FOV: 45 degrees; color fundus photograph
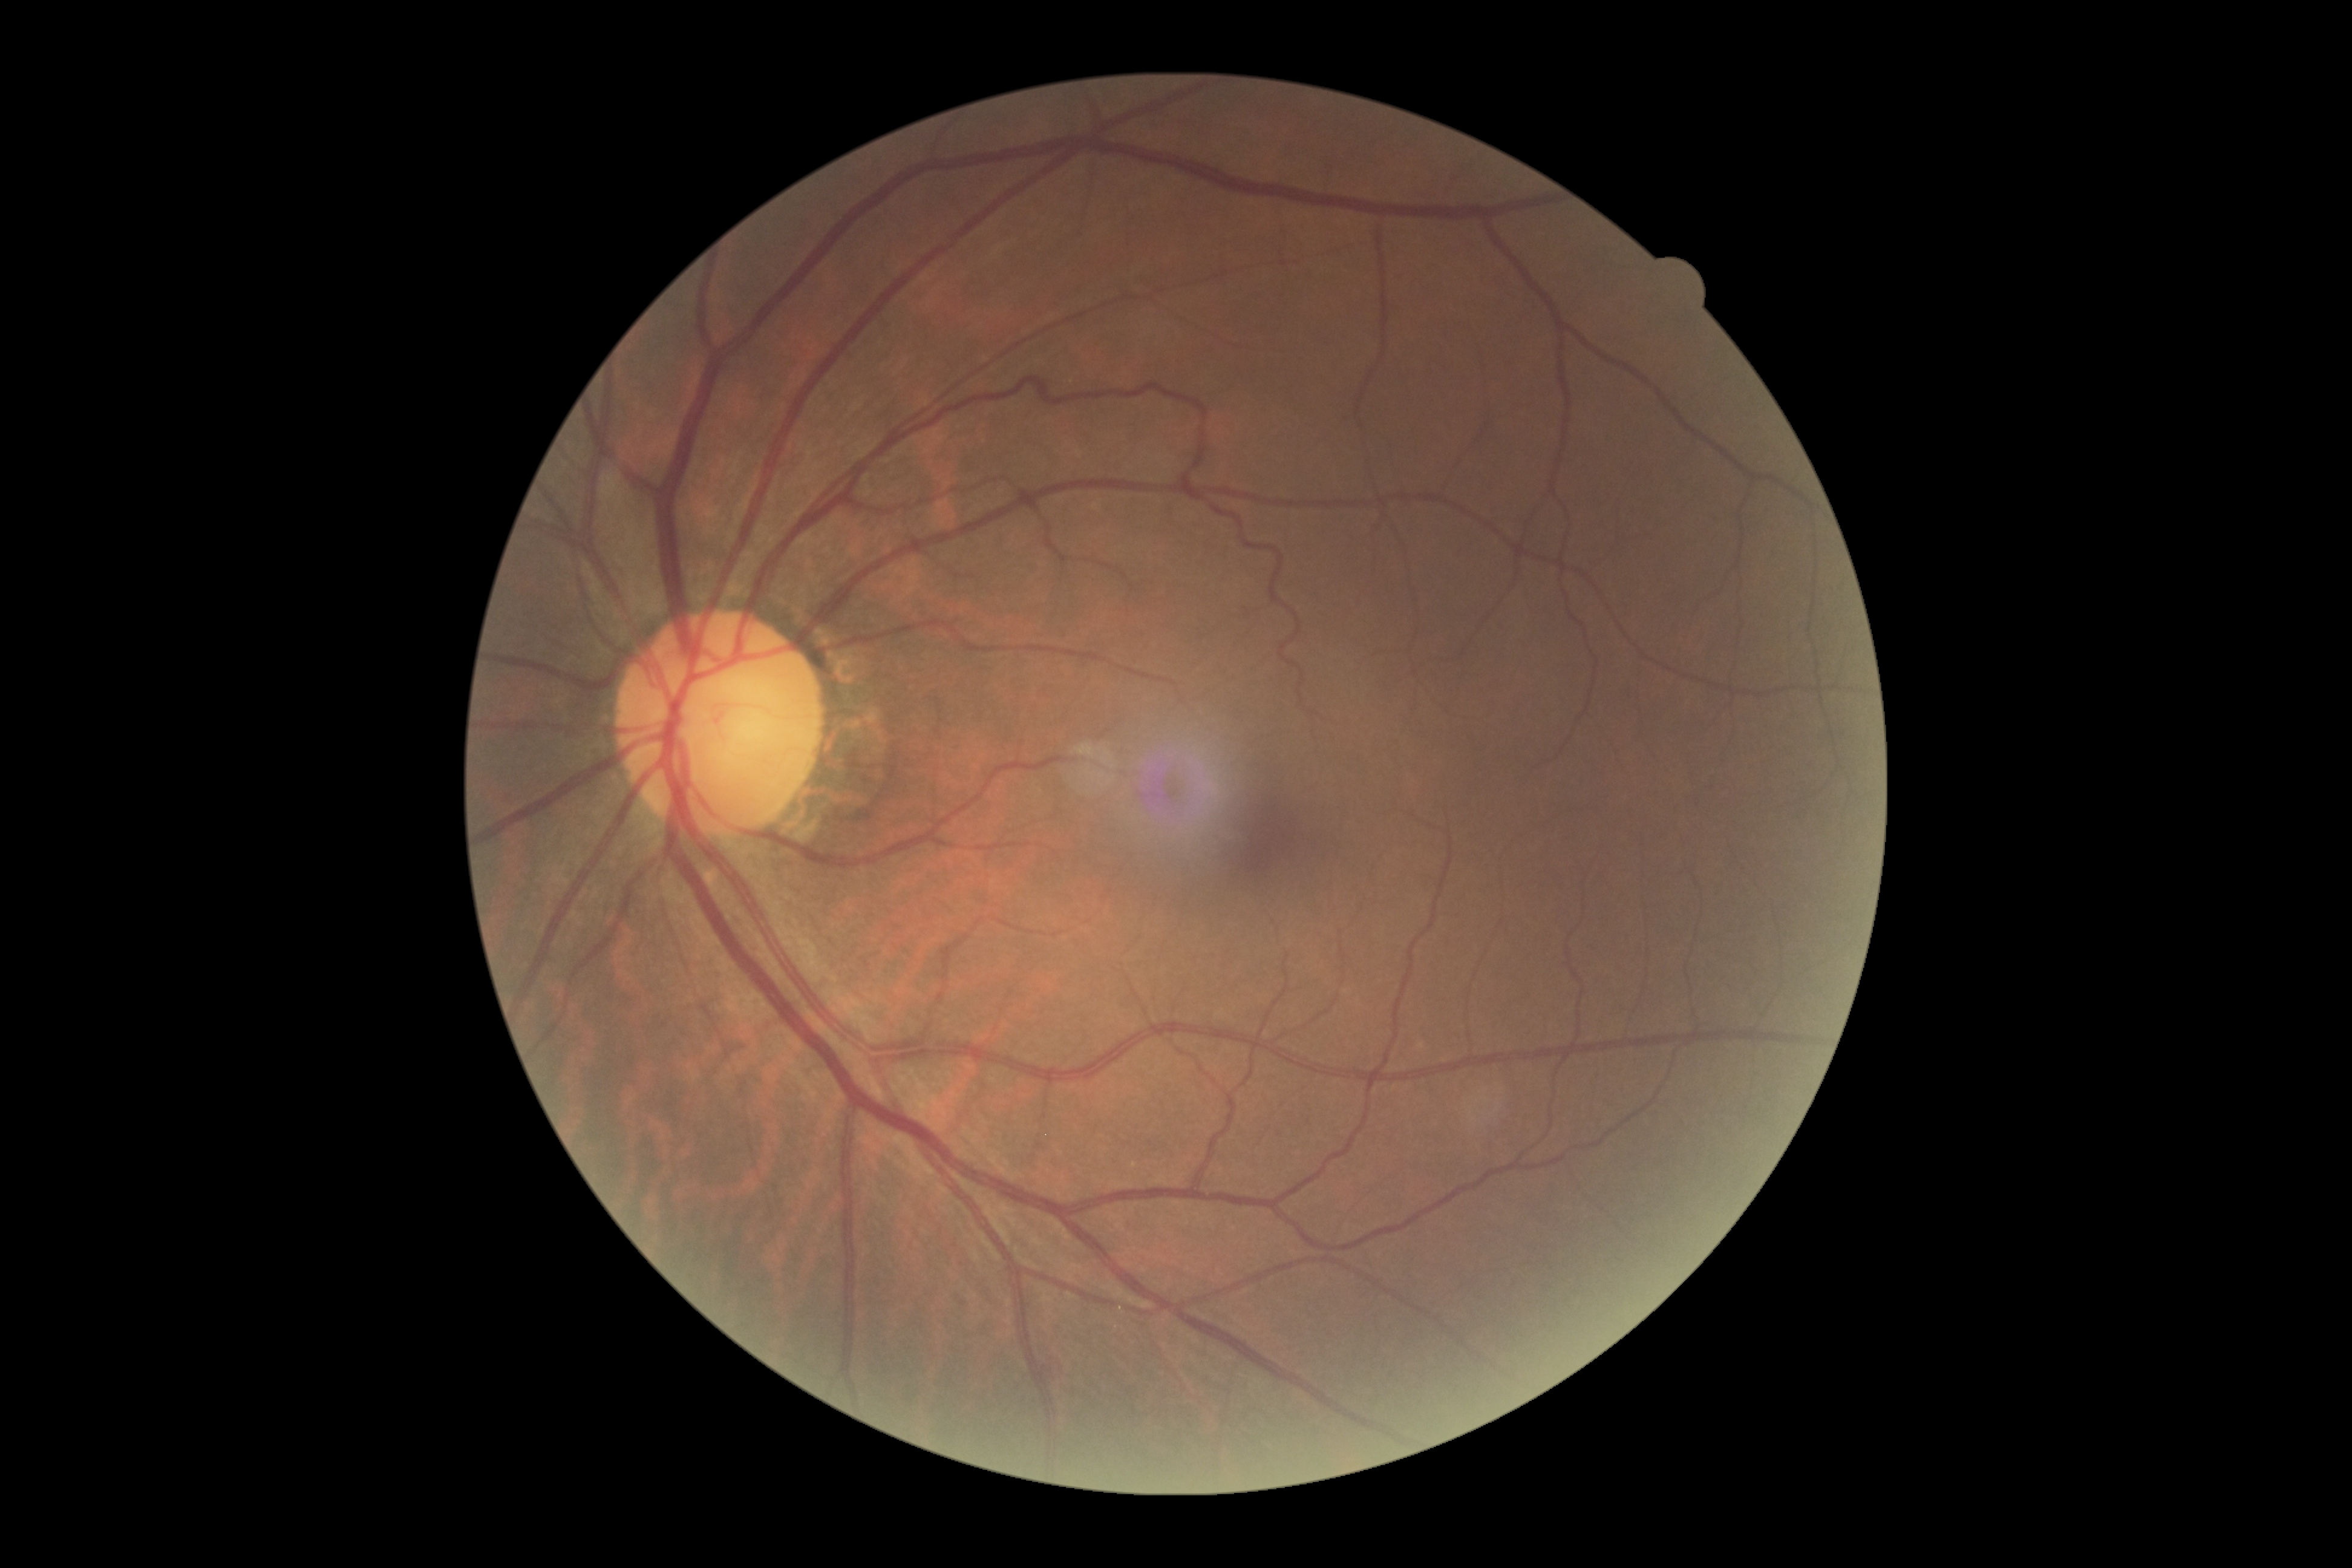

DR is 0.